Retinal fundus photograph.
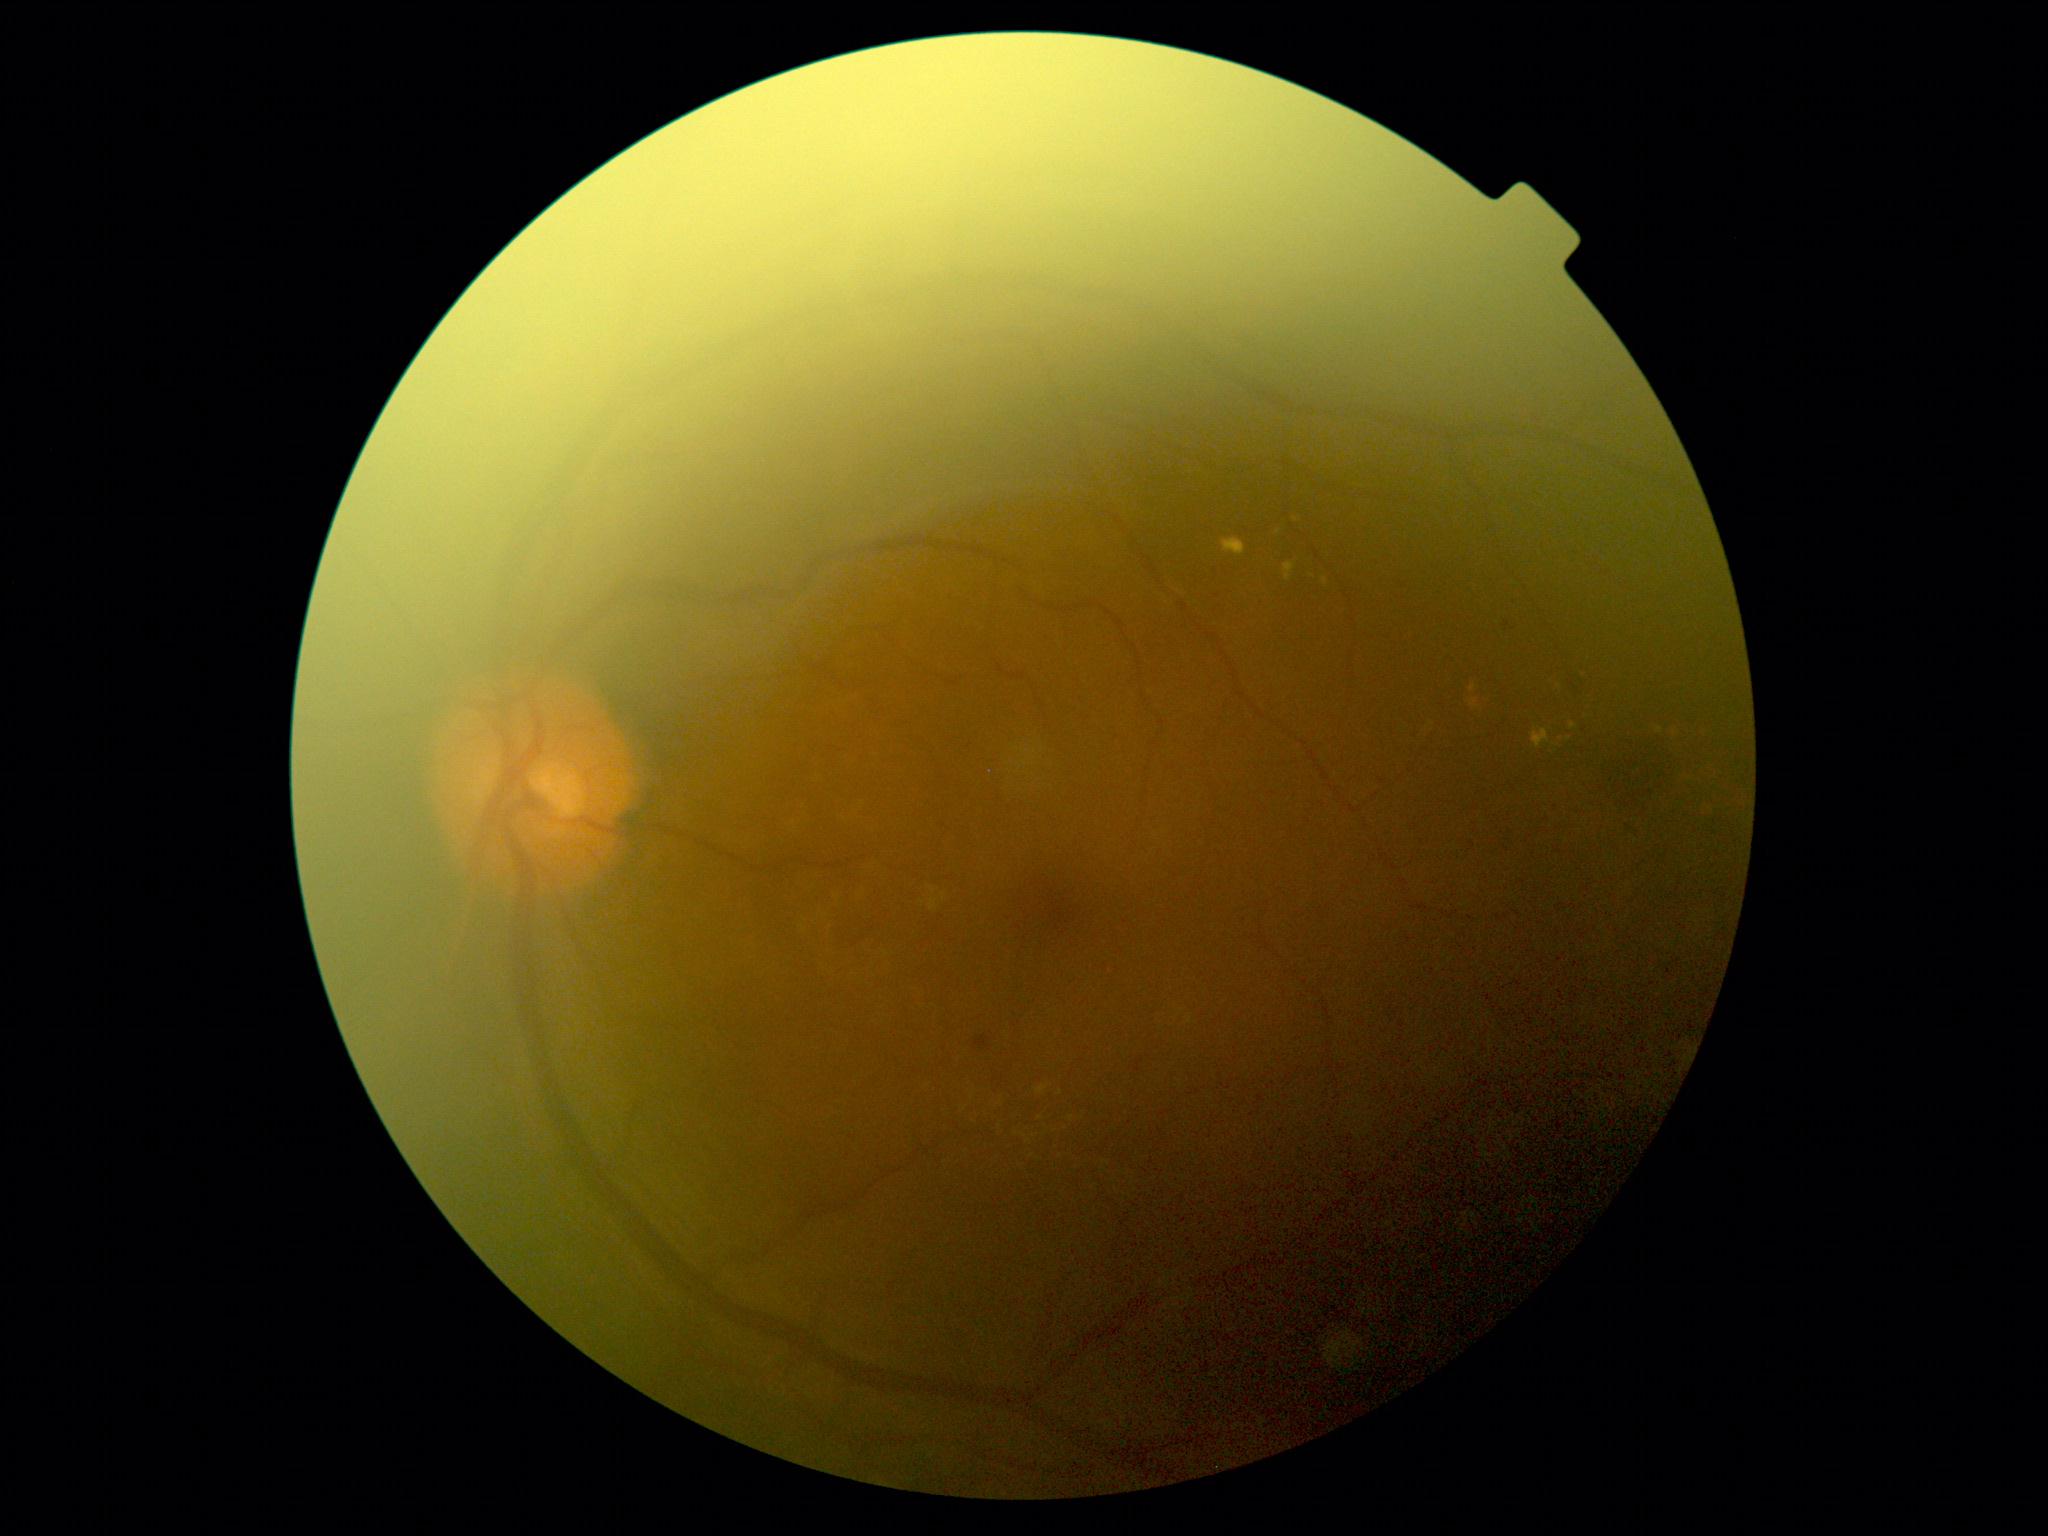 DR: 2.